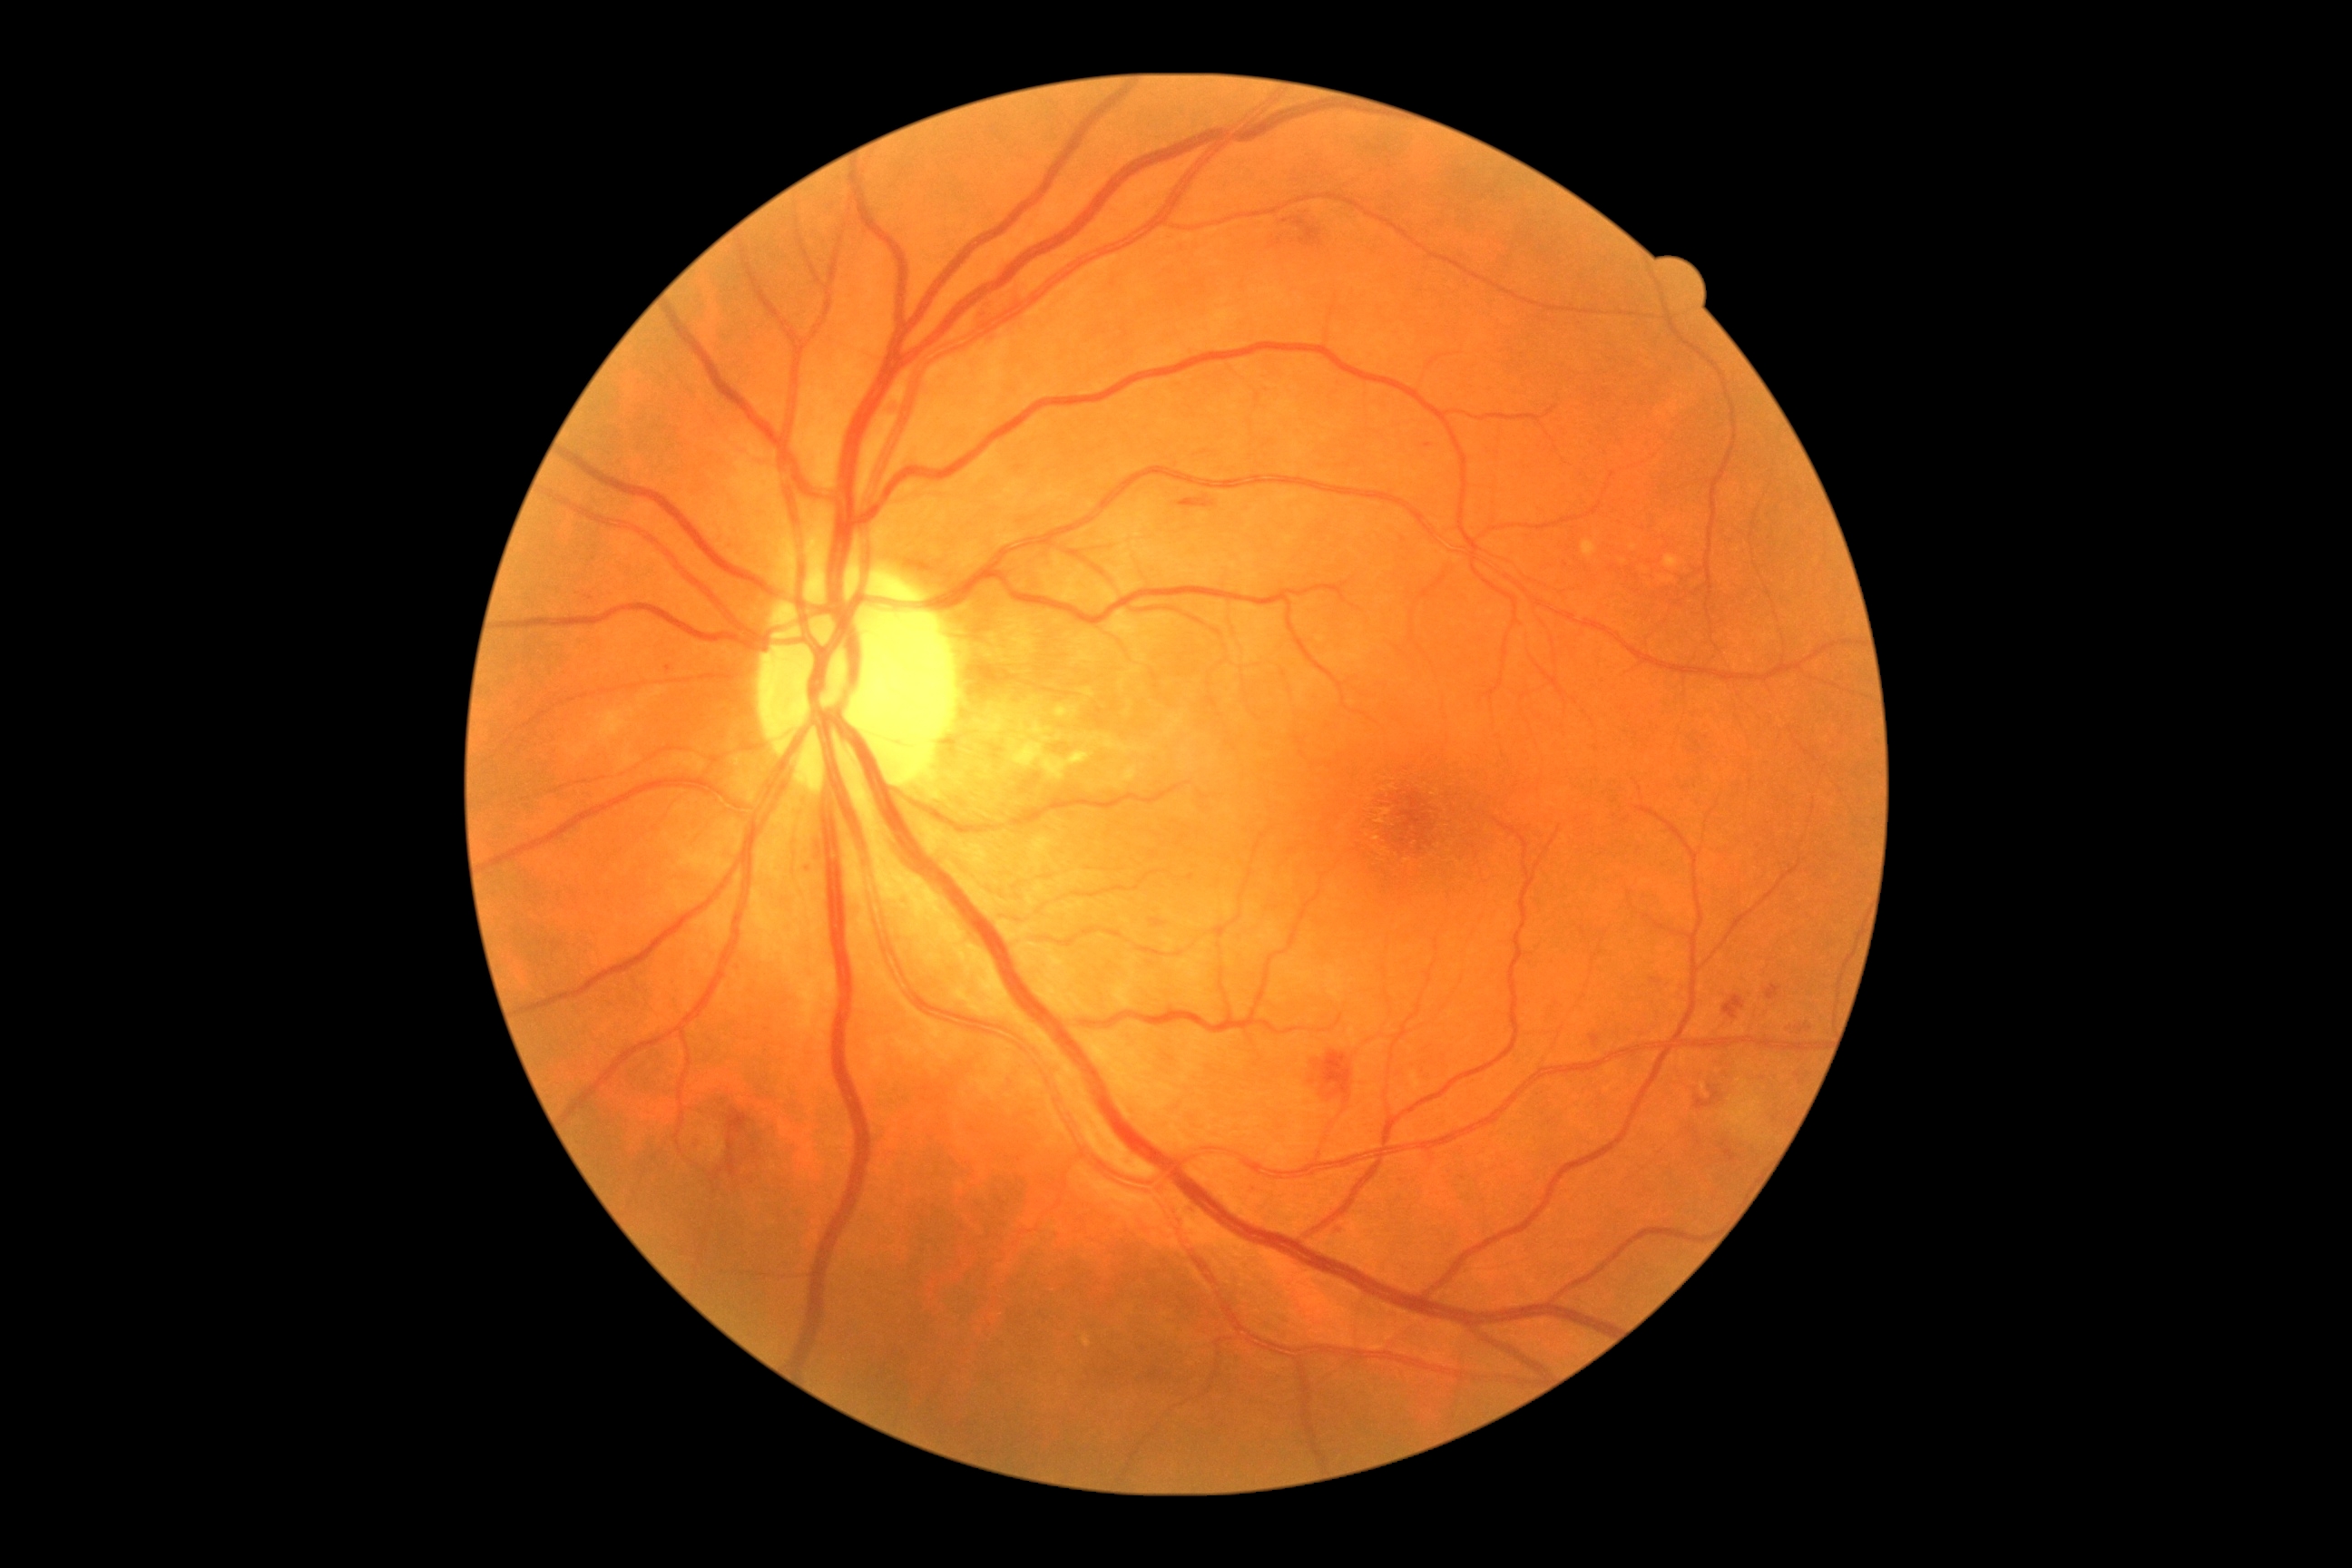
Diabetic retinopathy (DR) is grade 2
Lesions identified (partial list):
- hemorrhages (HEs) (partial): l=1694, t=1086, r=1720, b=1112 | l=729, t=1108, r=750, b=1135 | l=1591, t=1035, r=1600, b=1046 | l=729, t=1155, r=738, b=1177 | l=1723, t=995, r=1745, b=1021 | l=729, t=1137, r=734, b=1152 | l=1767, t=985, r=1781, b=1001 | l=1315, t=1052, r=1353, b=1099 | l=887, t=404, r=899, b=422 | l=1282, t=217, r=1320, b=246 | l=1179, t=495, r=1215, b=507 | l=1652, t=979, r=1660, b=985 | l=1723, t=1148, r=1738, b=1162
- Additional small HEs near x=720 y=1172
- hard exudates (EXs) (partial): l=1660, t=576, r=1674, b=583 | l=1665, t=554, r=1680, b=569 | l=1583, t=540, r=1598, b=558
- Additional small EXs near x=1634 y=547 | x=1624 y=562
- microaneurysms (MAs): l=1342, t=1228, r=1349, b=1239 | l=808, t=865, r=816, b=872
- Additional small MAs near x=669 y=669 | x=1429 y=445 | x=1139 y=1340
- soft exudates (SEs): l=705, t=1128, r=727, b=1162 | l=1727, t=1099, r=1759, b=1130